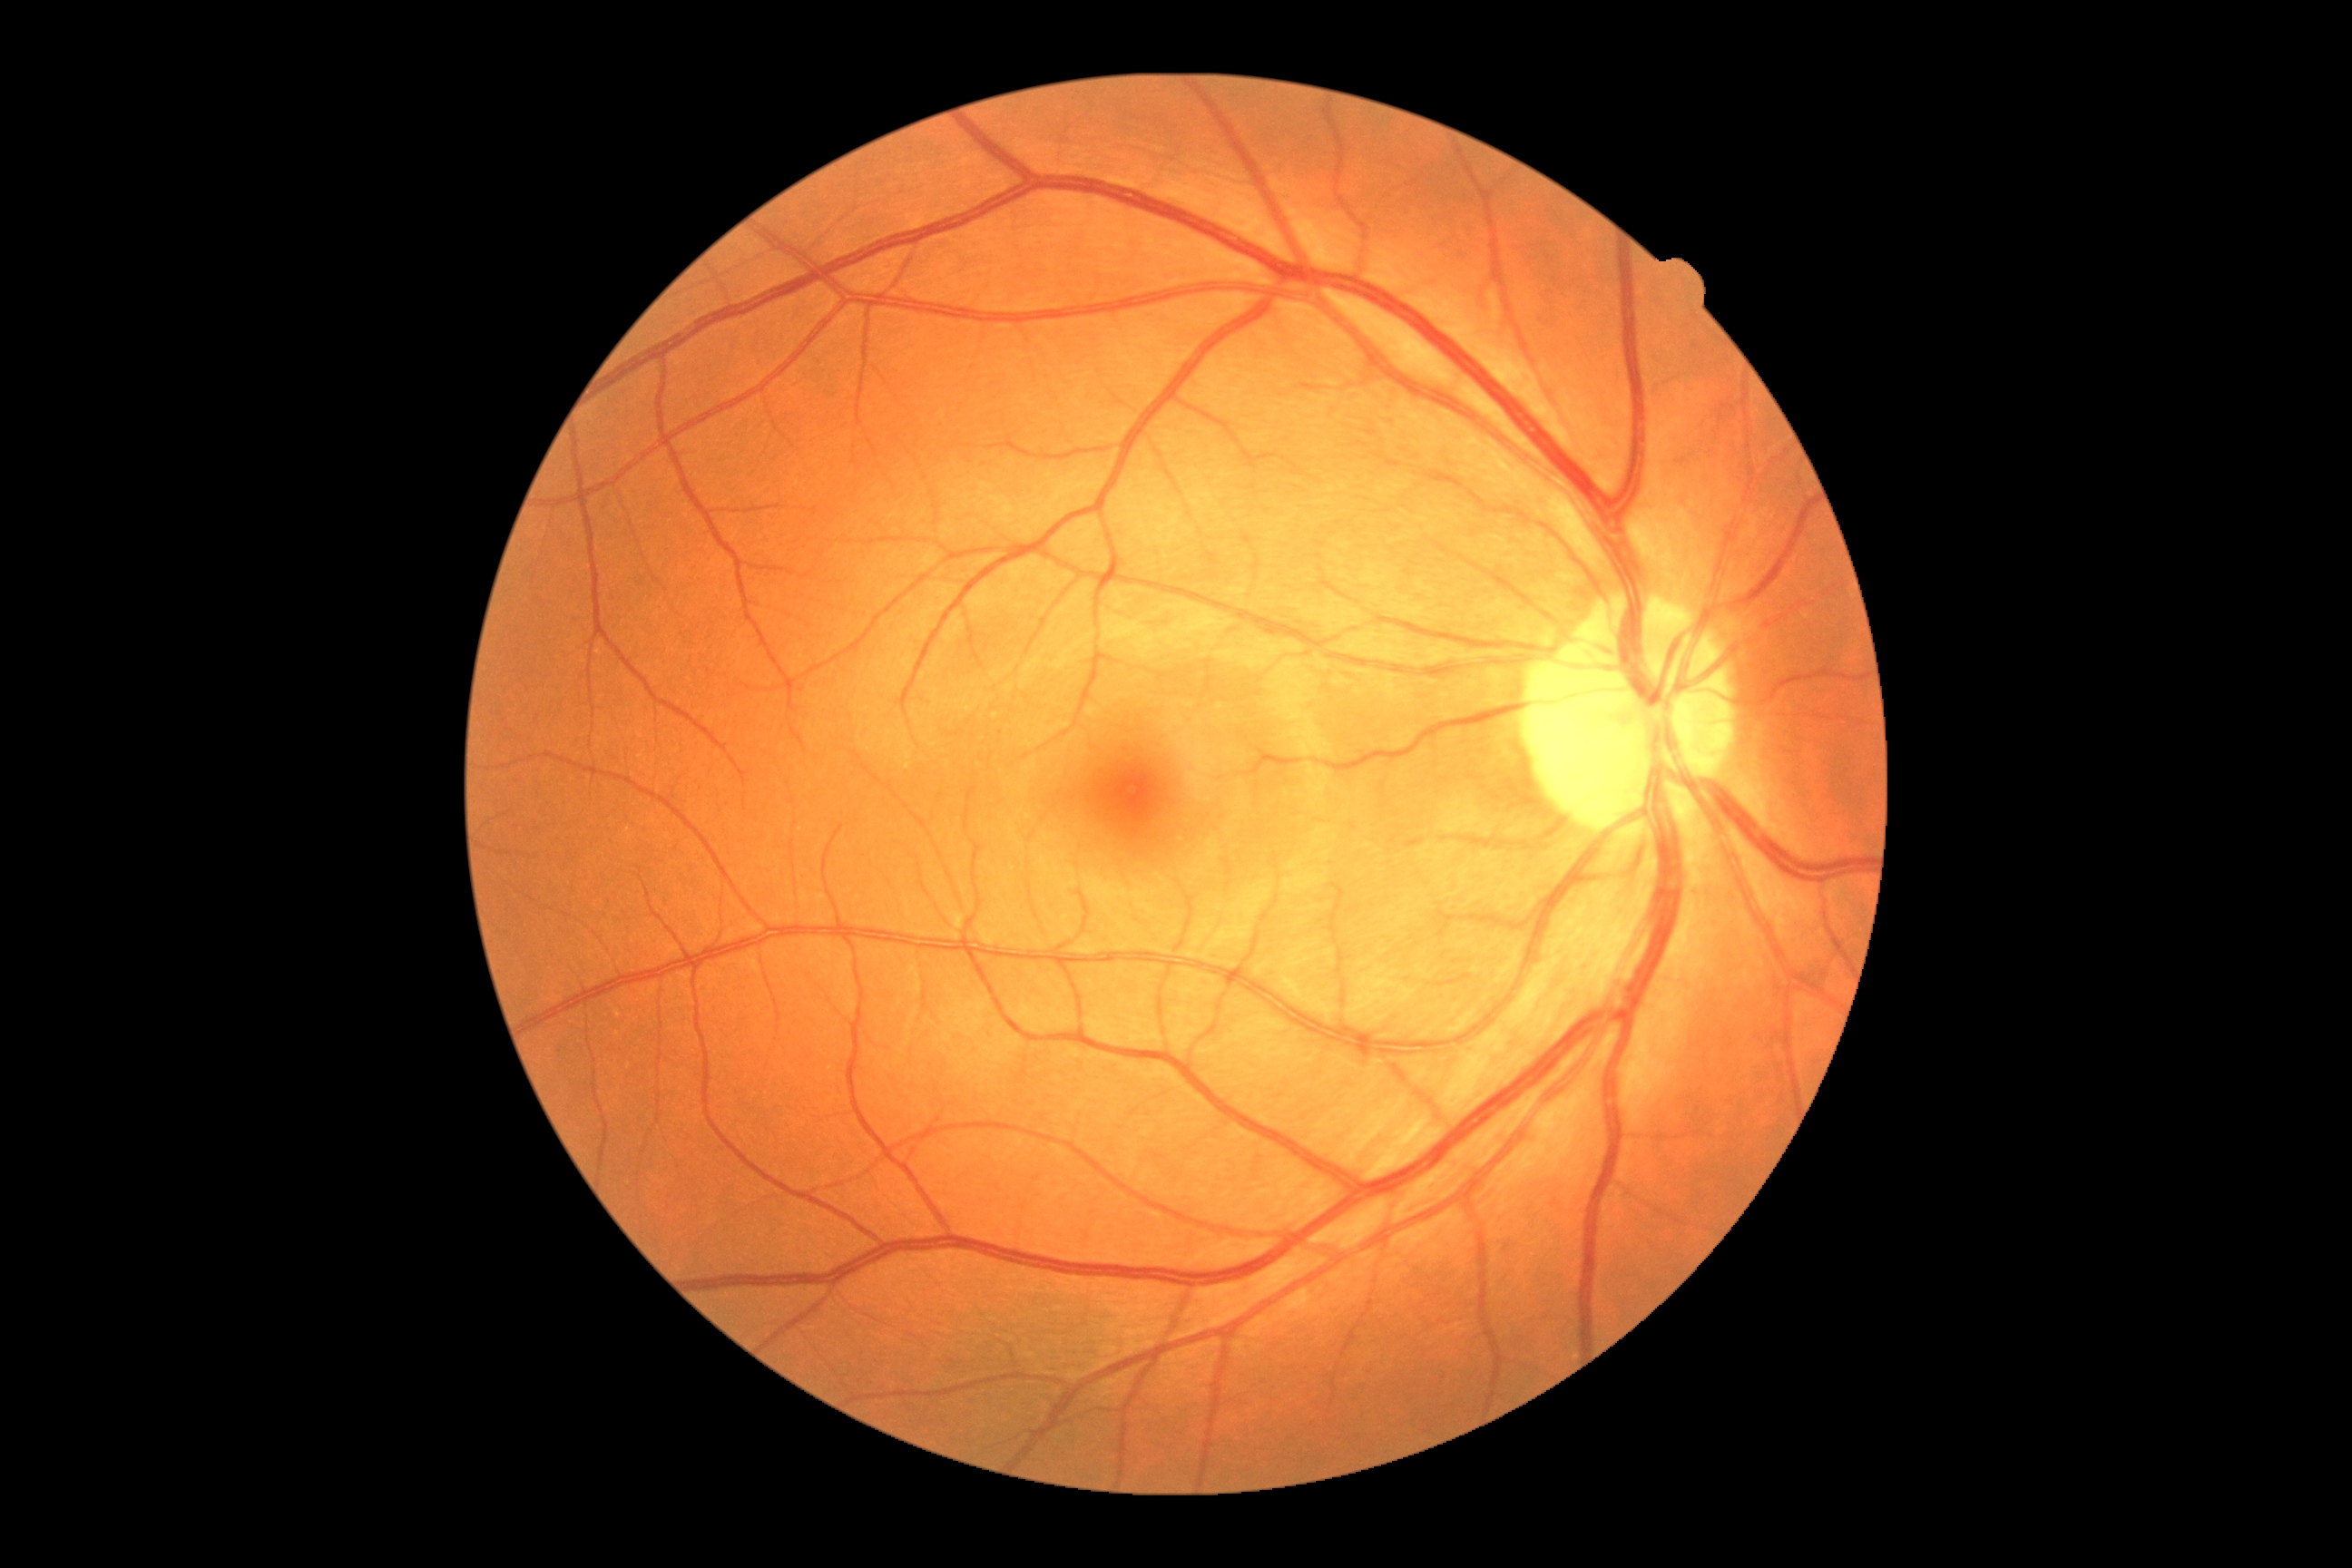

DR: no apparent diabetic retinopathy (grade 0) — no visible signs of diabetic retinopathy.